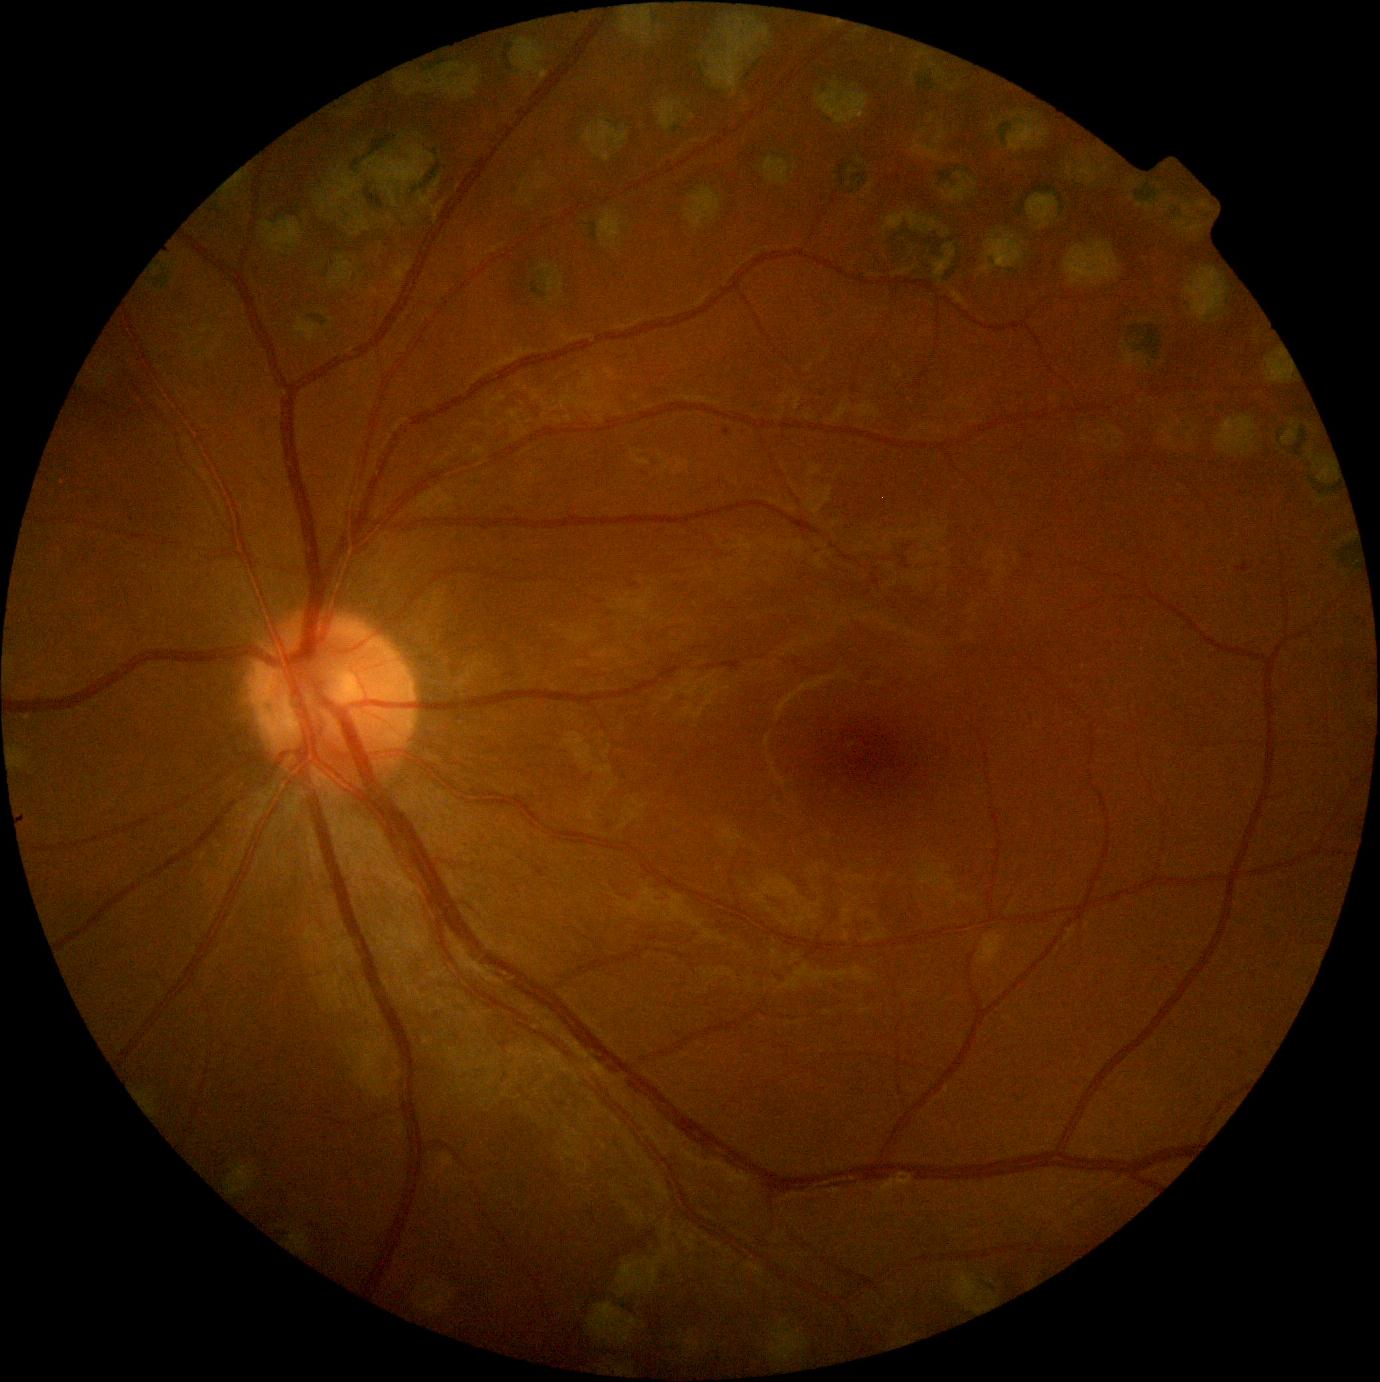
Diabetic retinopathy (DR) is grade 1 (mild NPDR) — presence of microaneurysms only.